Retinal fundus photograph
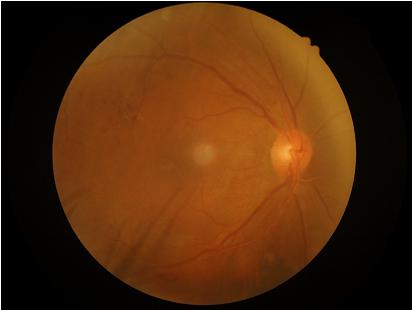
Acceptable image quality. Good dynamic range. Poor illumination with uneven exposure.